640x480px · pediatric wide-field fundus photograph · acquired on the Clarity RetCam 3: 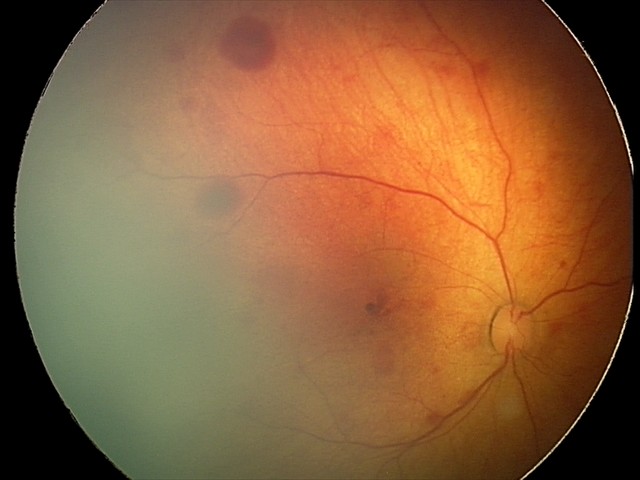

Series diagnosed as retinal hemorrhages.